FOV: 45 degrees — 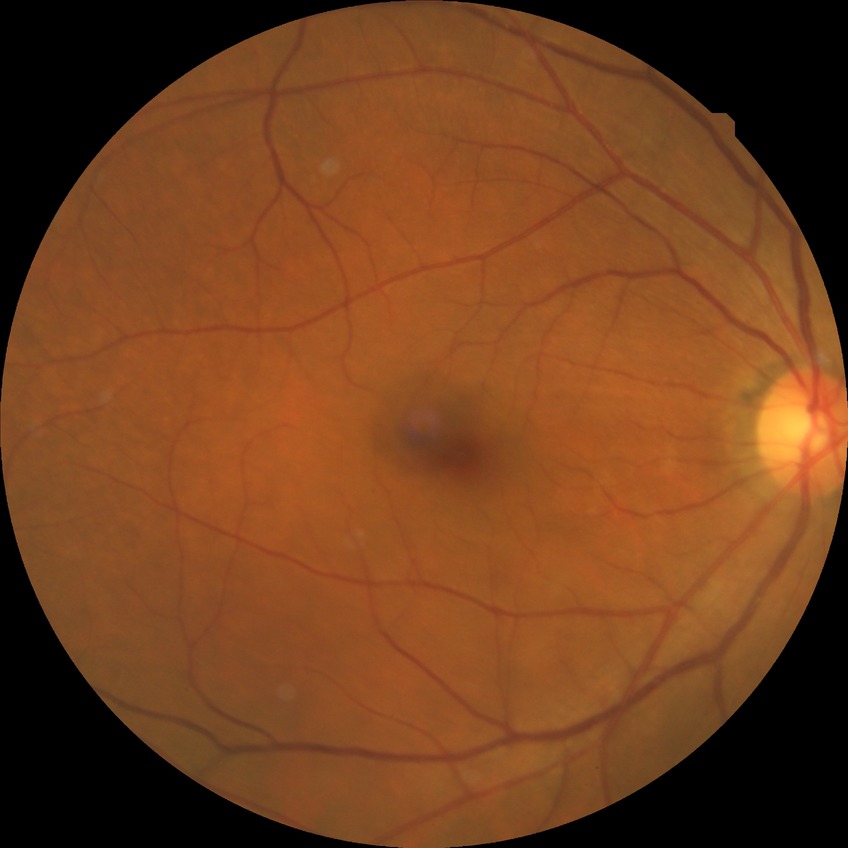

No DR findings. DR stage is NDR.